45° field of view; color fundus photograph: 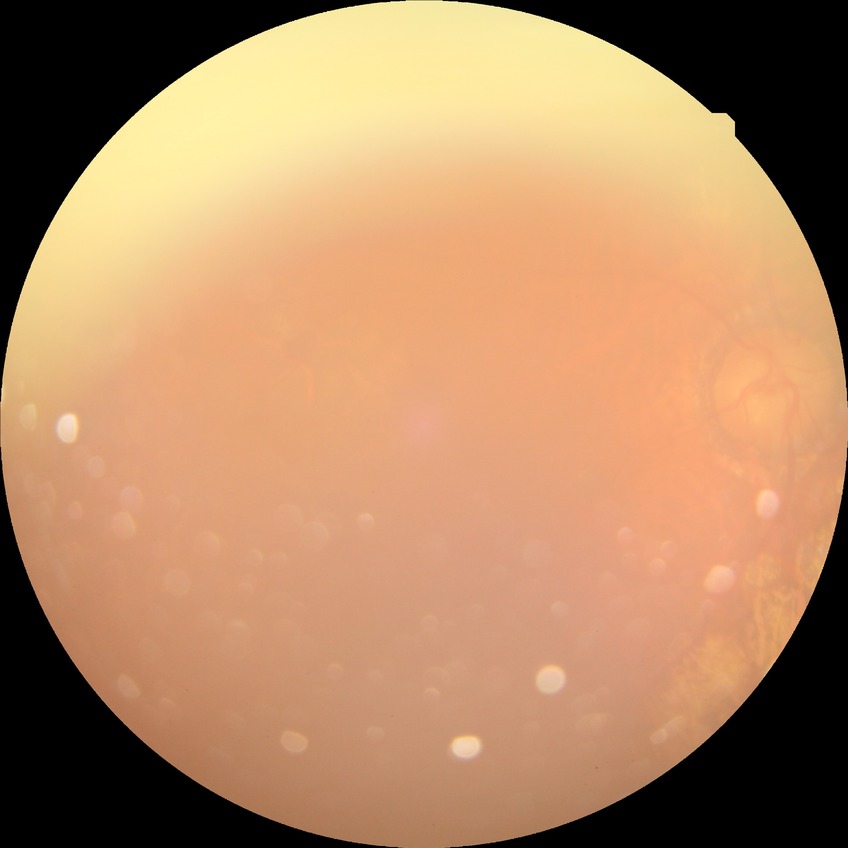
{"davis_grade": "PDR (proliferative diabetic retinopathy)"}